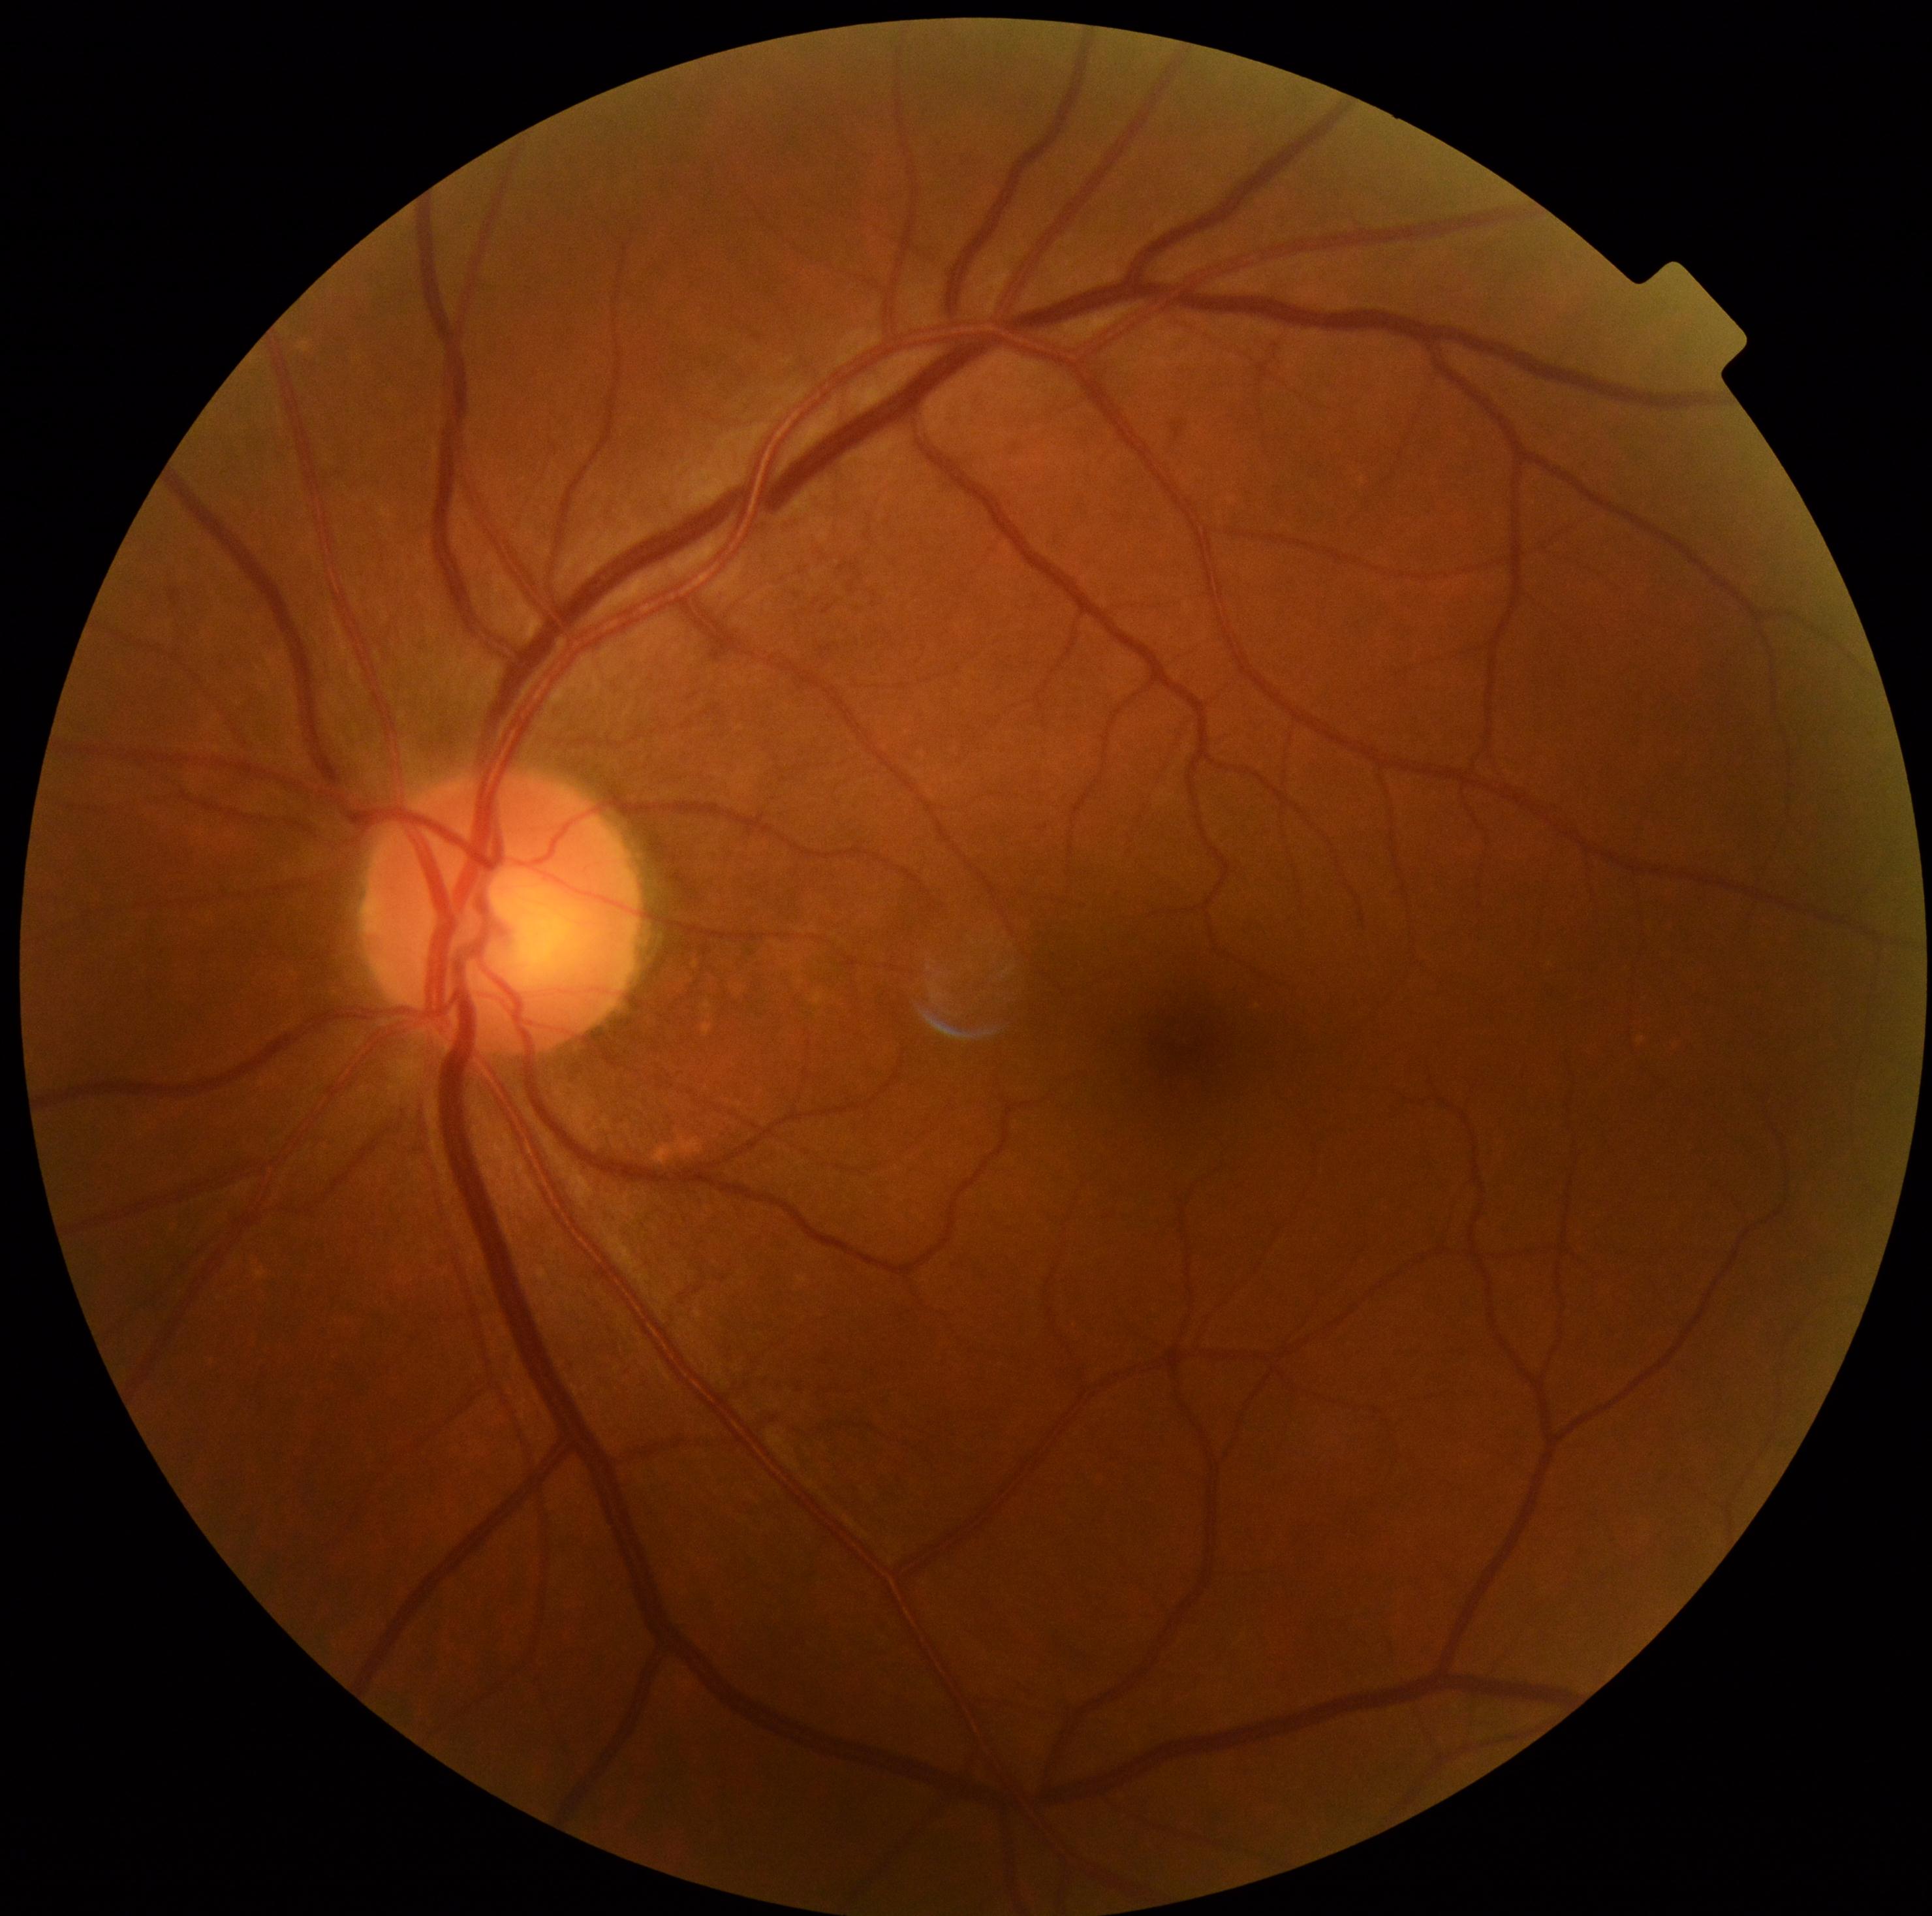
DR severity is grade 0 (no apparent retinopathy).